Captured on a Remidio smartphone fundus camera — 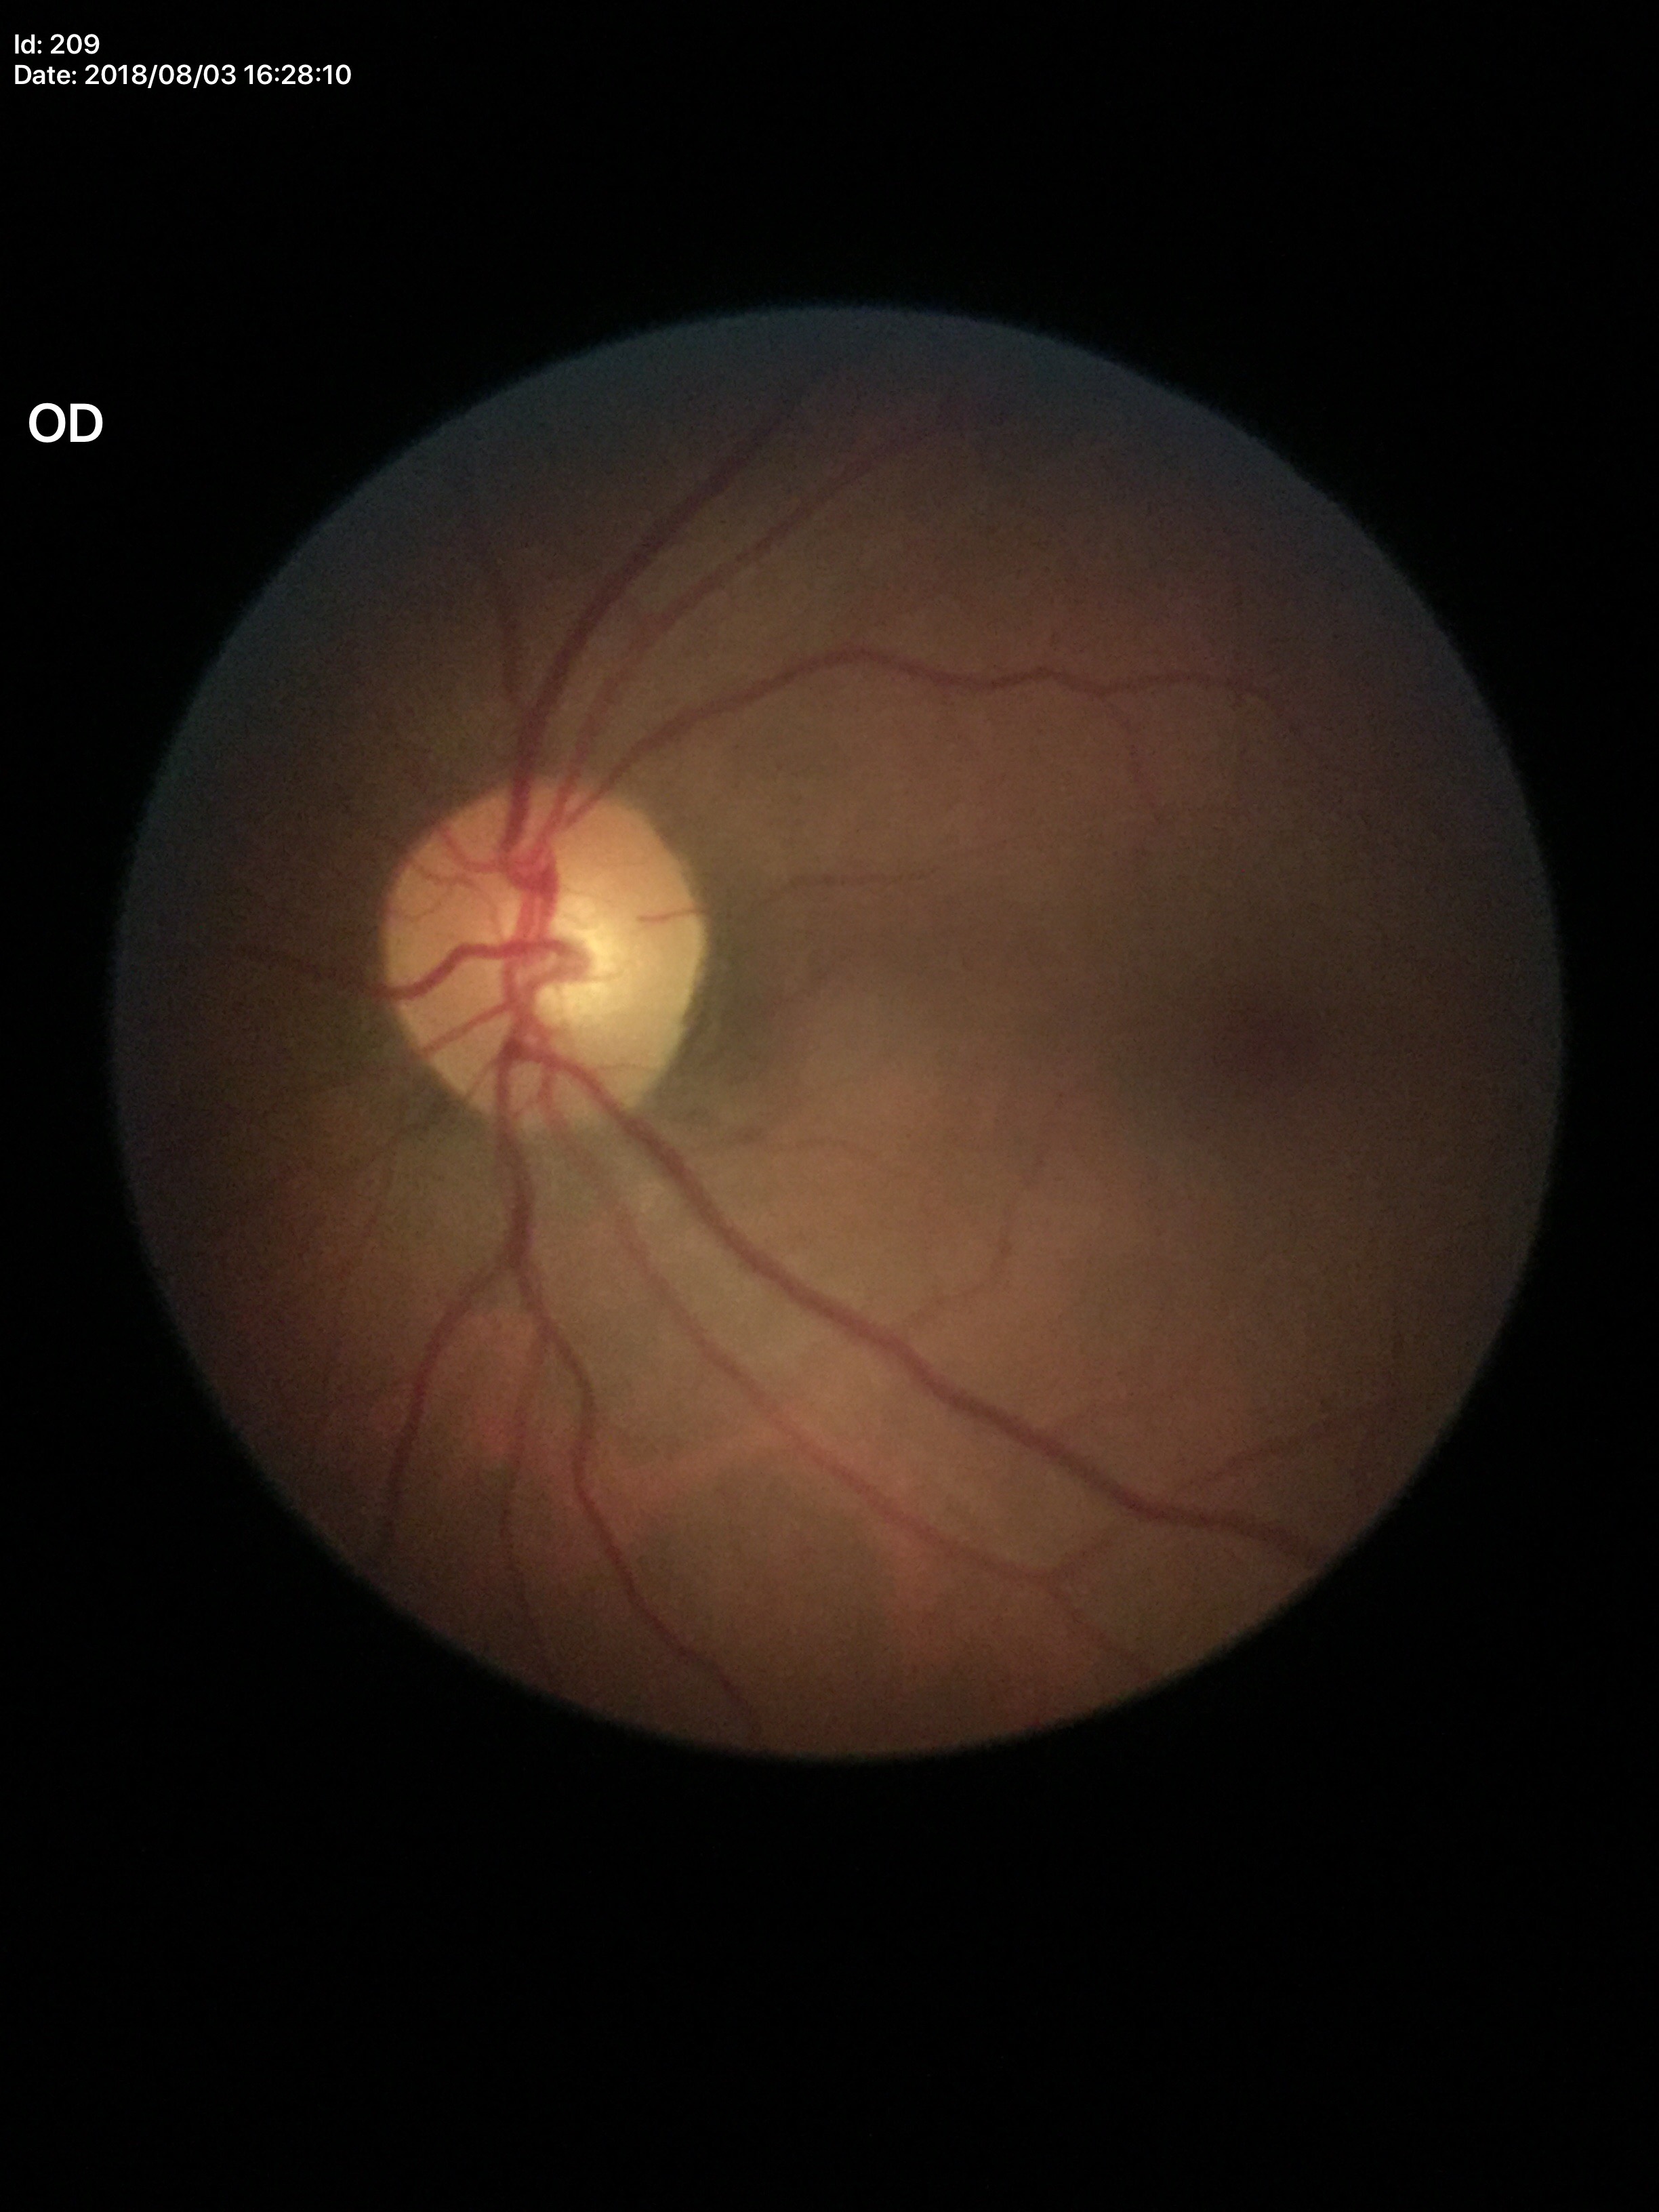
Glaucoma assessment=no suspicious findings | horizontal CDR=0.49 | vertical CDR=0.49 | area cup-to-disc ratio=0.25